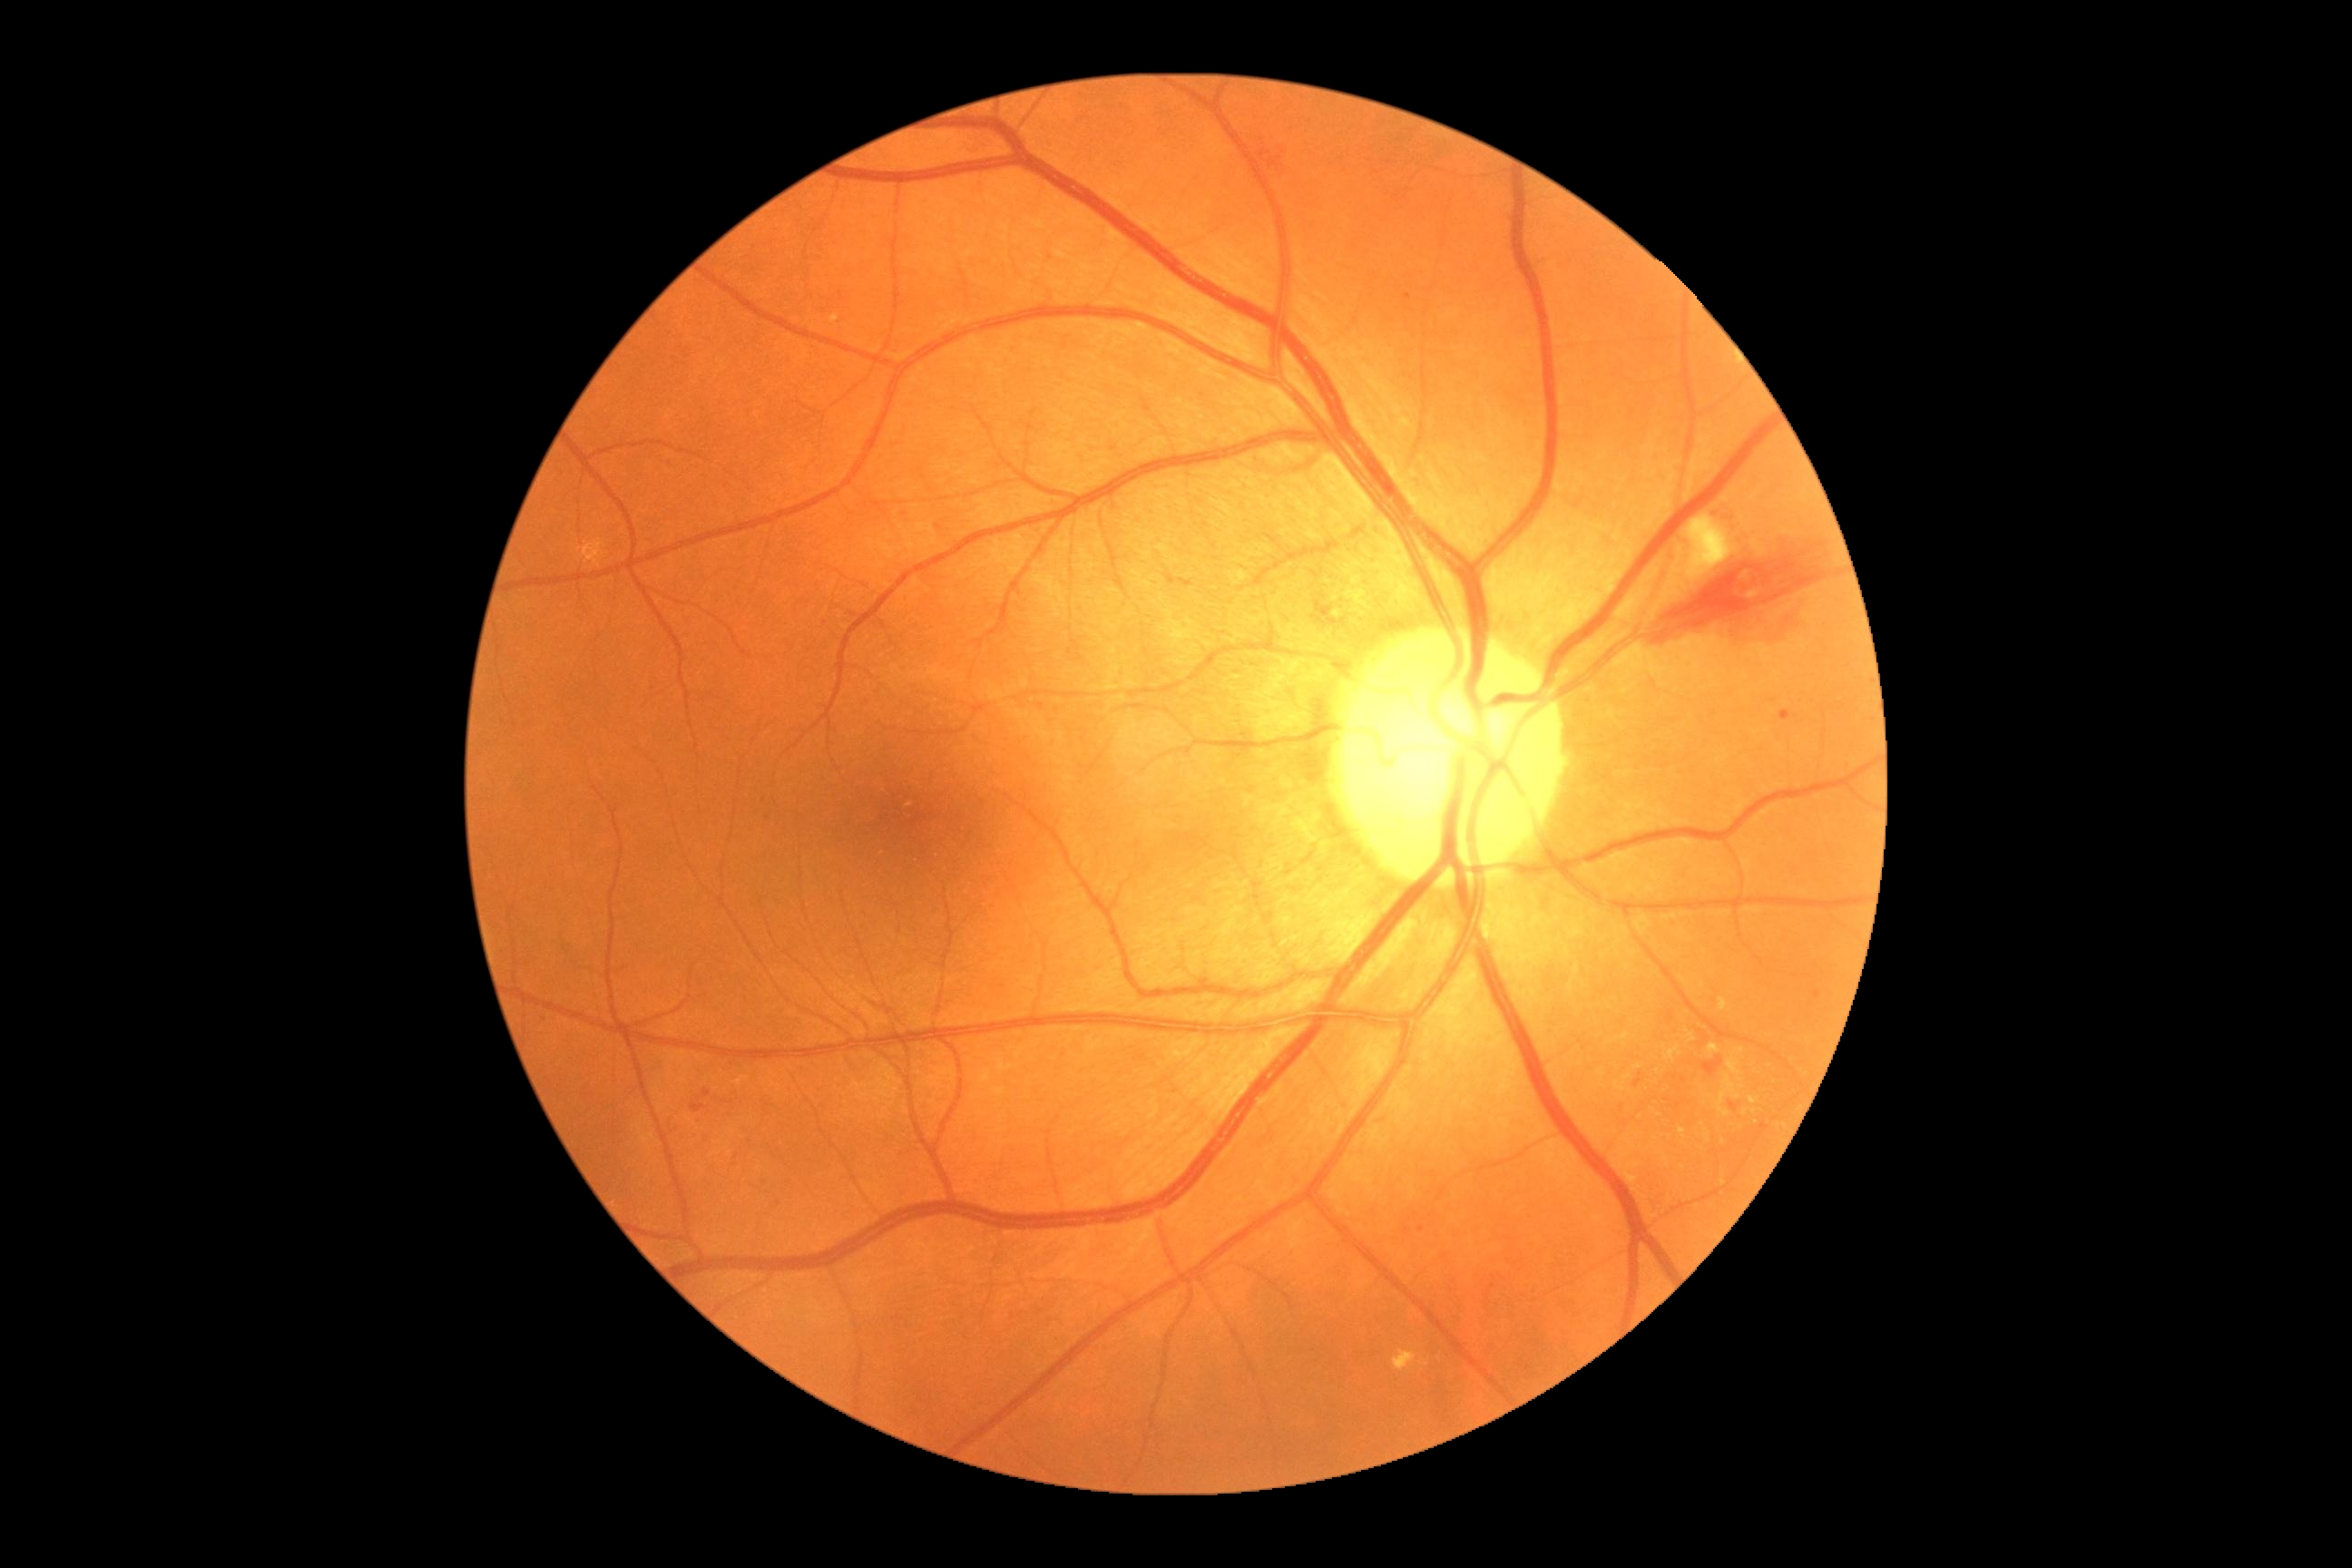
{"partial":true,"dr_grade":2,"lesions":{"ma":null,"ex":[[1687,1035,1696,1043],[1665,1046,1681,1061],[1663,1159,1671,1164],[1678,1128,1685,1139],[1716,1075,1743,1119],[1709,1044,1720,1054],[1720,999,1729,1012],[1750,1097,1759,1106],[1727,1048,1745,1077]],"ex_small_centers":[[1754,1111],[1741,1081],[1707,1138],[1747,1112],[1724,1183],[1639,1068],[1724,1142]],"se":[[1687,516,1738,583]],"he":[[763,814,772,823],[1311,602,1331,622],[1779,710,1792,721],[1638,536,1843,647],[721,1101,729,1104],[761,798,770,803],[698,1090,712,1102],[660,458,680,471],[1729,1102,1738,1112]],"he_small_centers":[[1681,1104],[1669,1100]]}}